Without pupil dilation; image size 848x848; Davis DR grading:
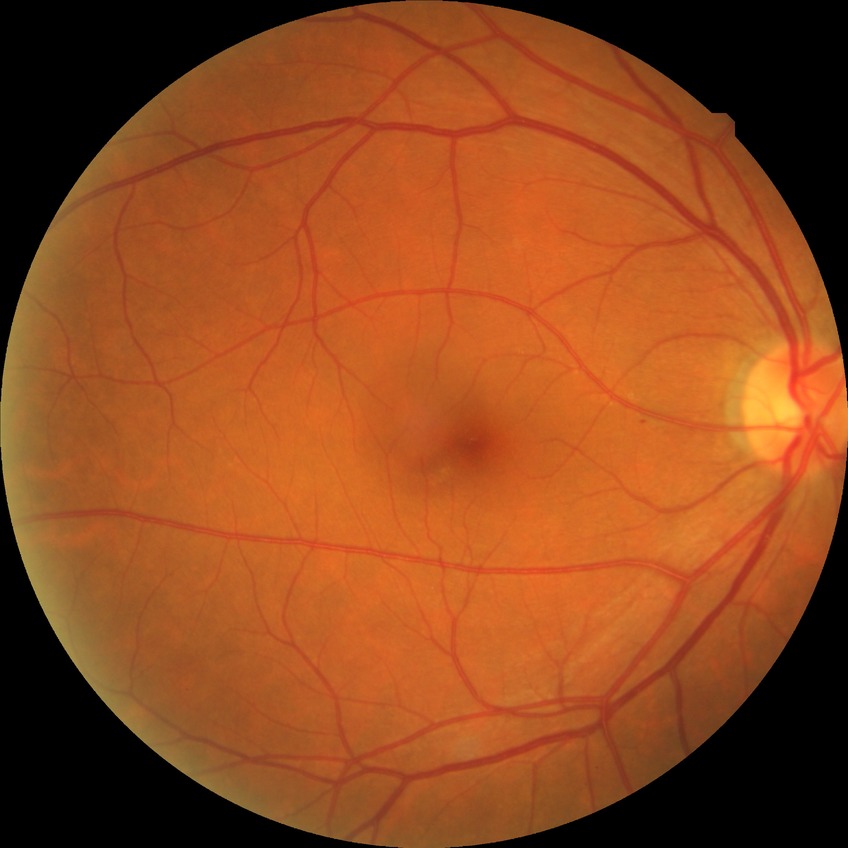
Modified Davis grading: no diabetic retinopathy.